Infant wide-field retinal image.
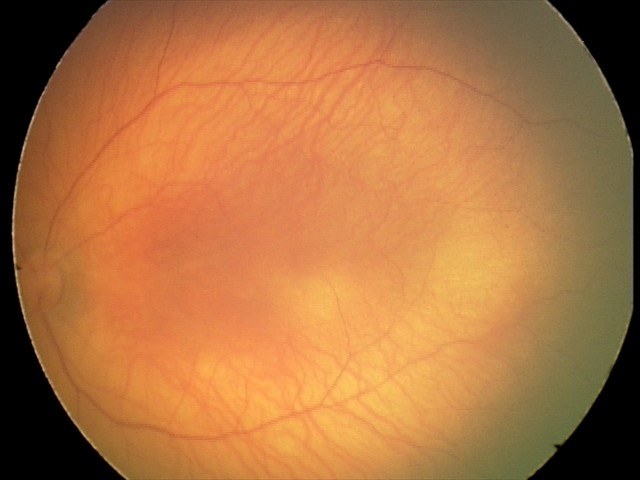
Diagnosis from this screening exam: retinal hemorrhages.